NIDEK AFC-230; 45 degree fundus photograph: 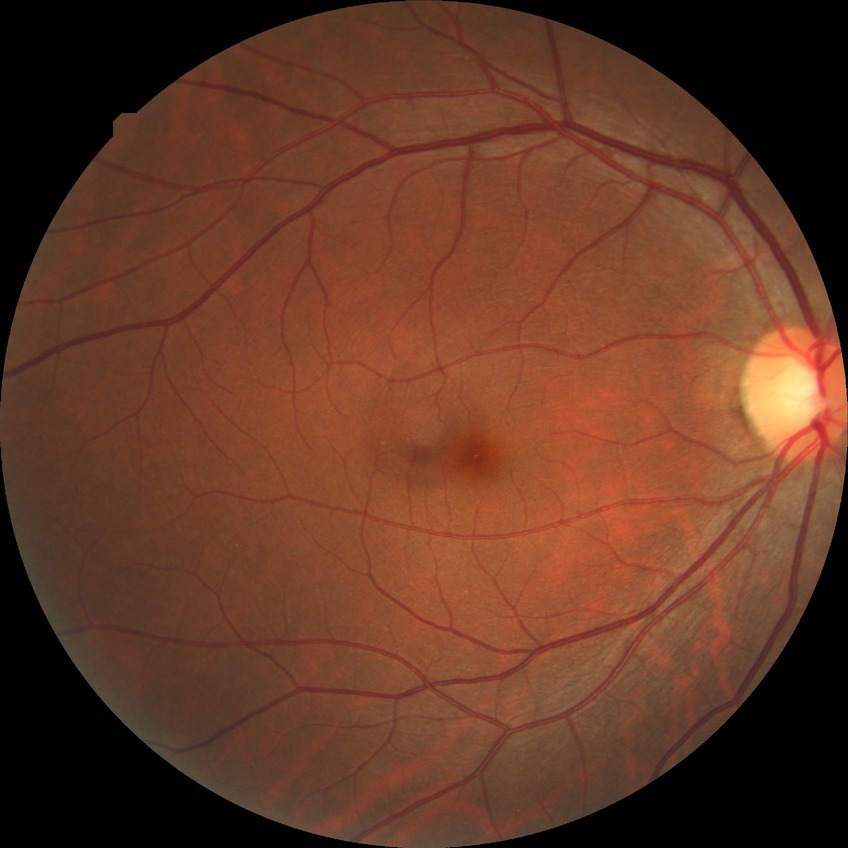

Diabetic retinopathy (DR): no diabetic retinopathy (NDR).